412x310. Tabletop color fundus camera image.
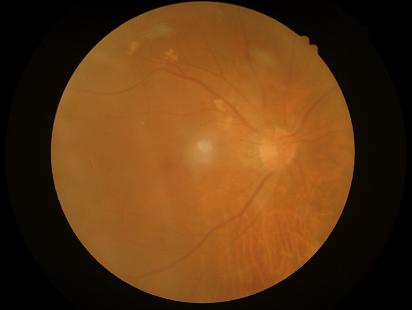 Contrast: low, vessels and details hard to distinguish; Overall quality: poor, ungradable; Illumination: good illumination and color balance; Clarity: reduced sharpness with visible blur.